Diabetic retinopathy graded by the modified Davis classification — 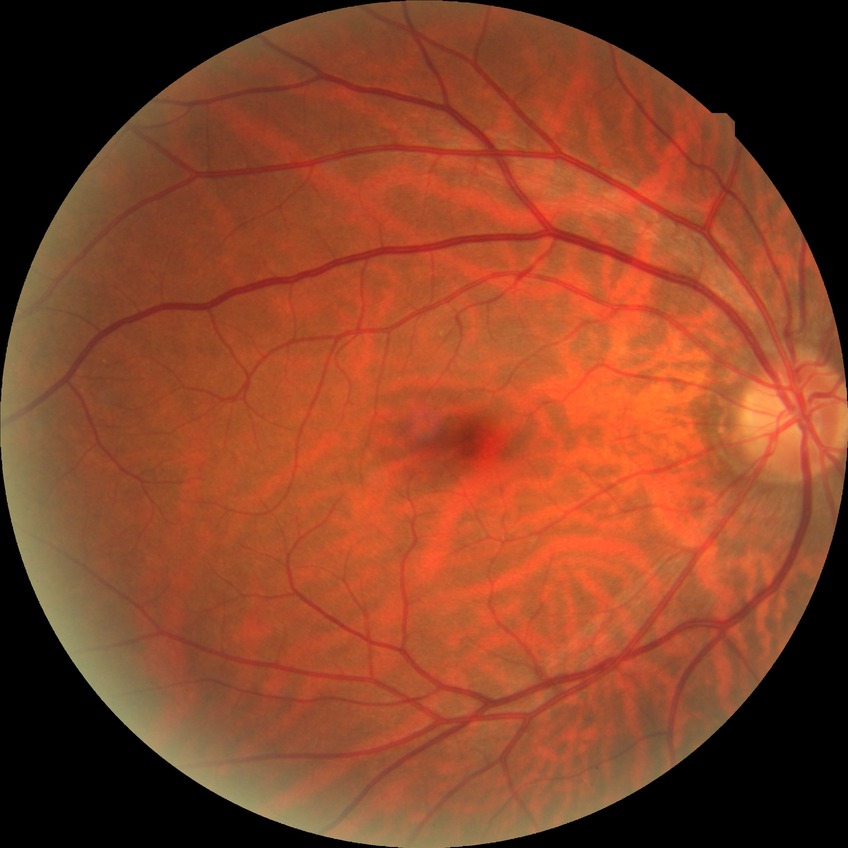

Diabetic retinopathy (DR) is NDR (no diabetic retinopathy).